NIDEK AFC-230 fundus camera. Nonmydriatic fundus photograph. 848 x 848 pixels
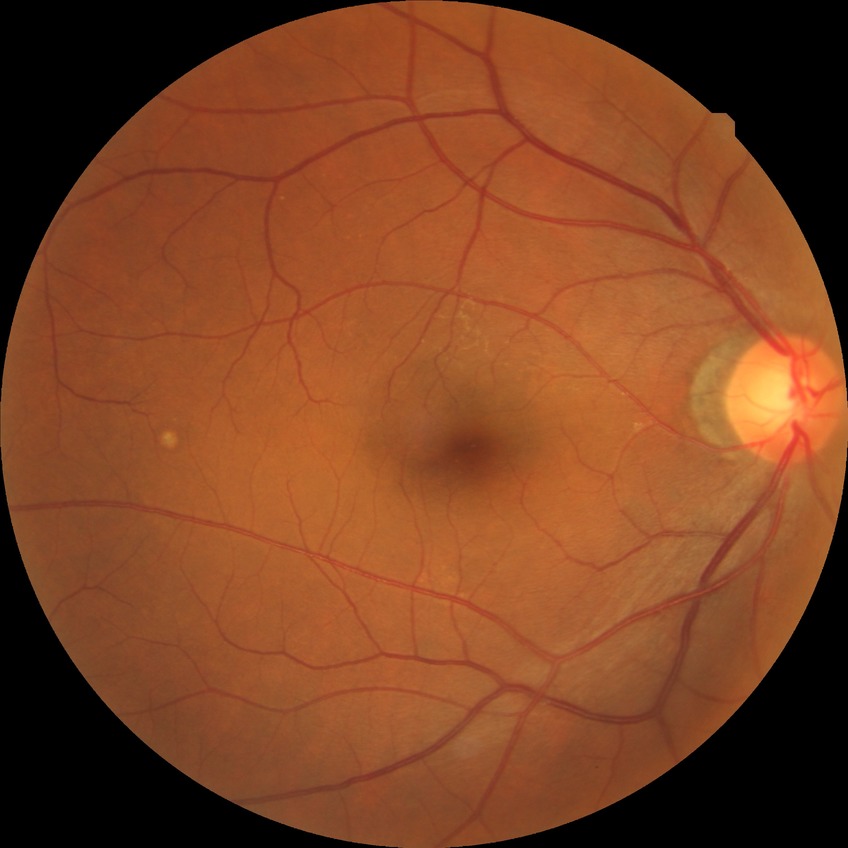 Diabetic retinopathy (DR) is no diabetic retinopathy (NDR).